Wide-field fundus photograph of an infant. Captured with the Phoenix ICON (100° field of view) — 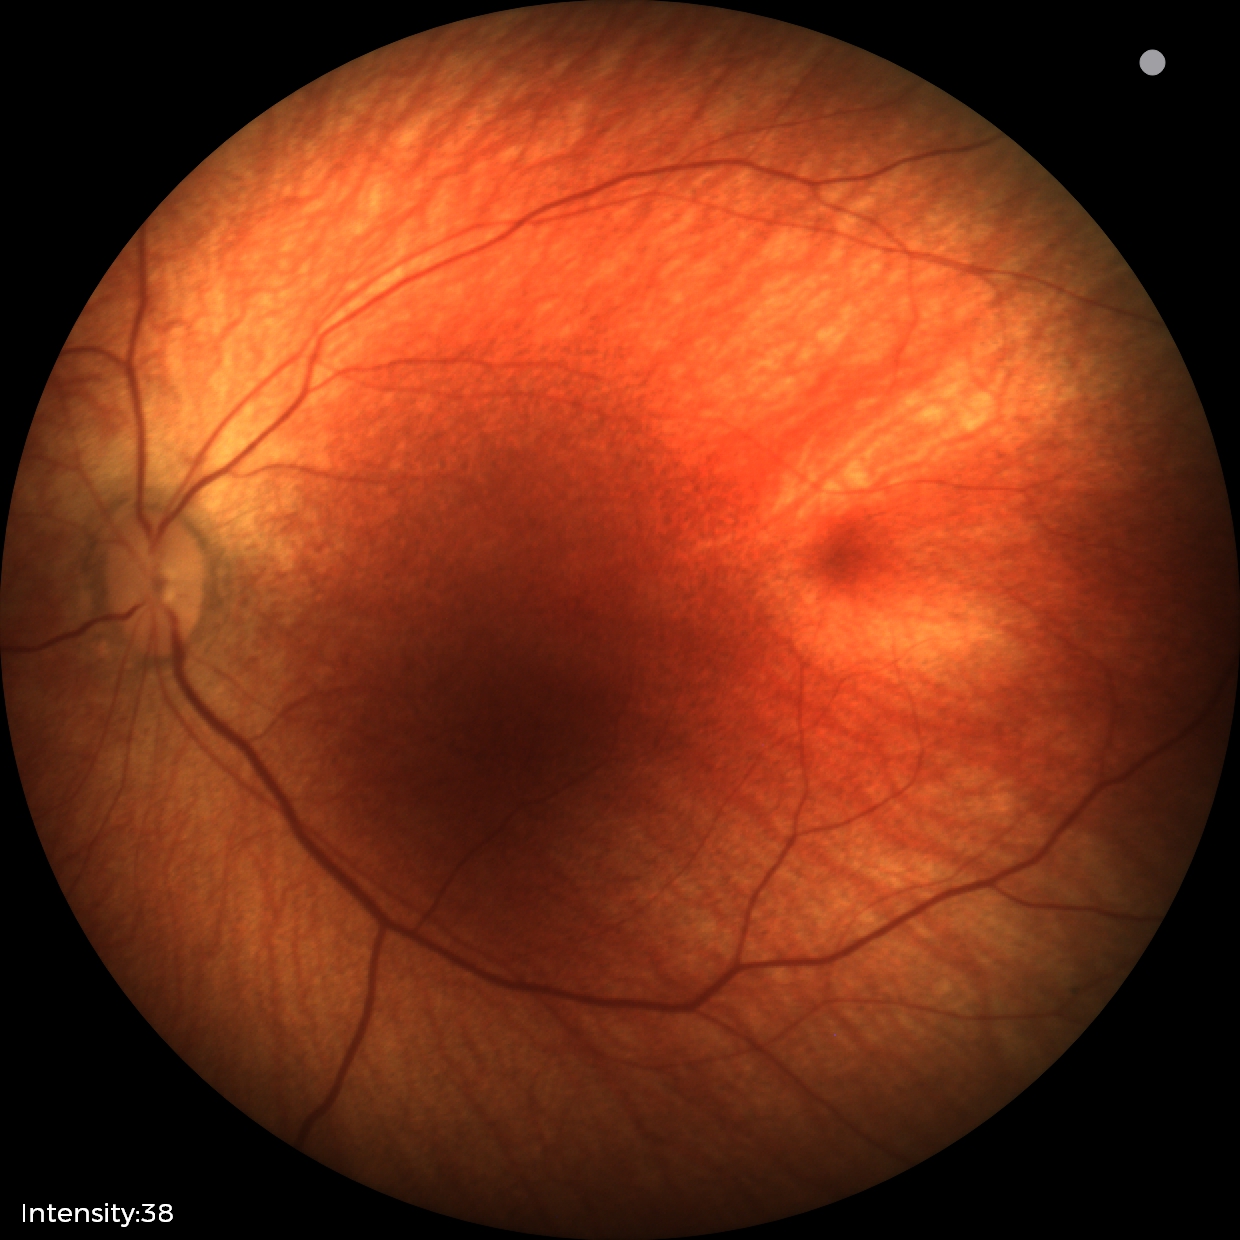 Q: What was the screening finding?
A: physiological finding